Camera: Phoenix ICON (100° FOV) · infant wide-field retinal image
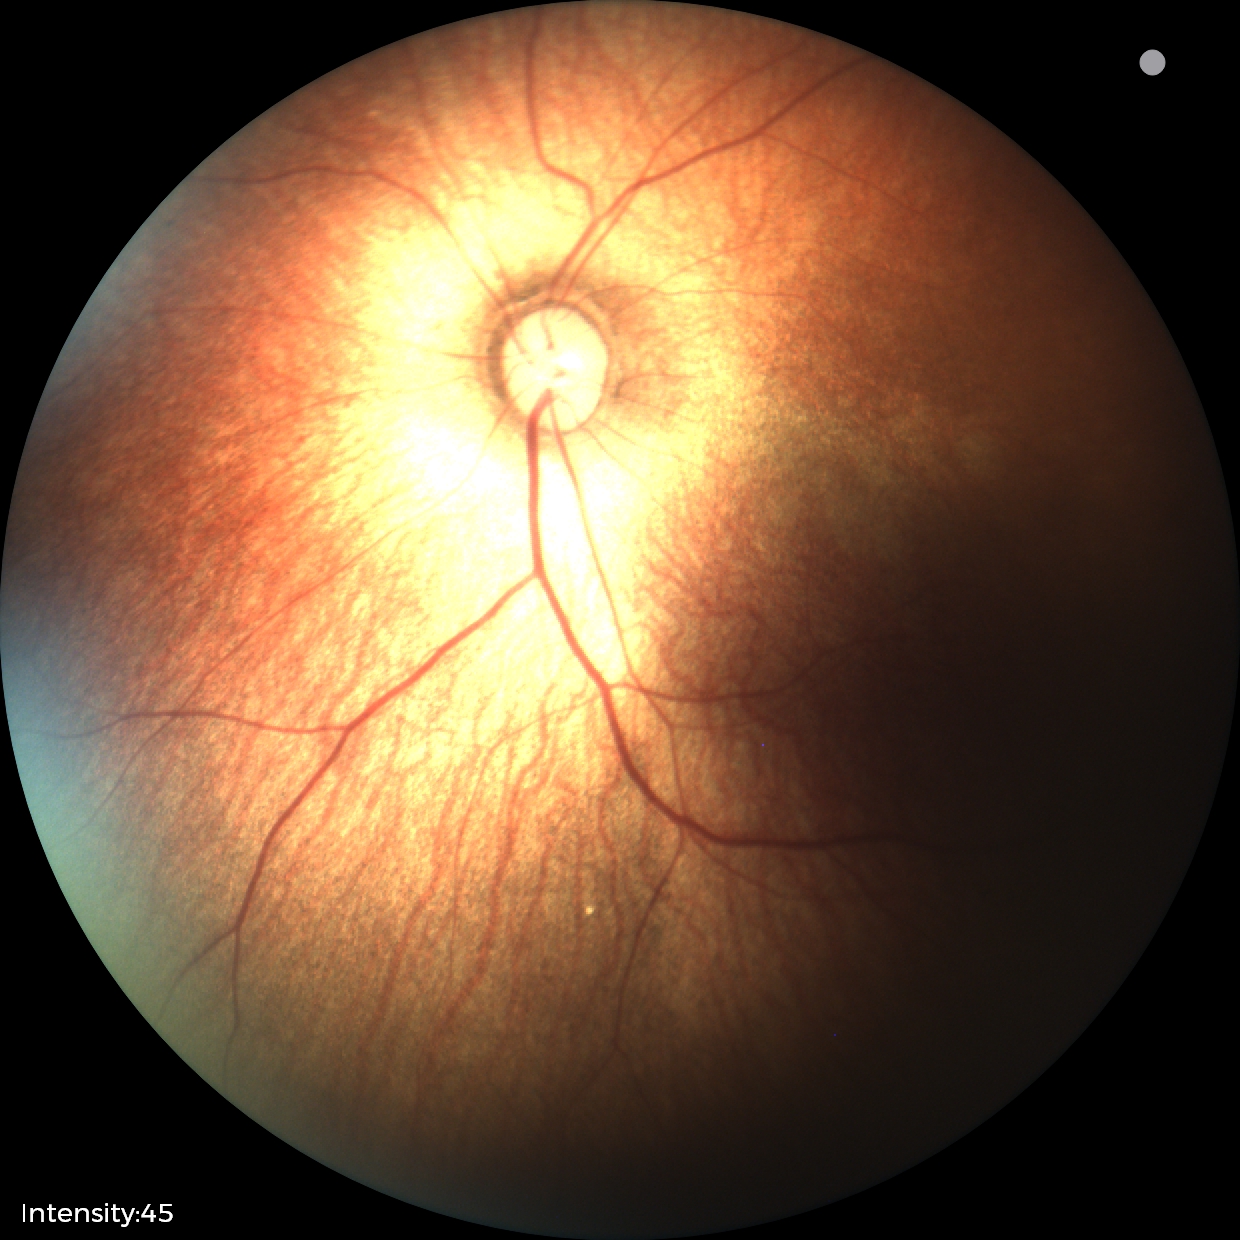

Examination with physiological retinal findings.